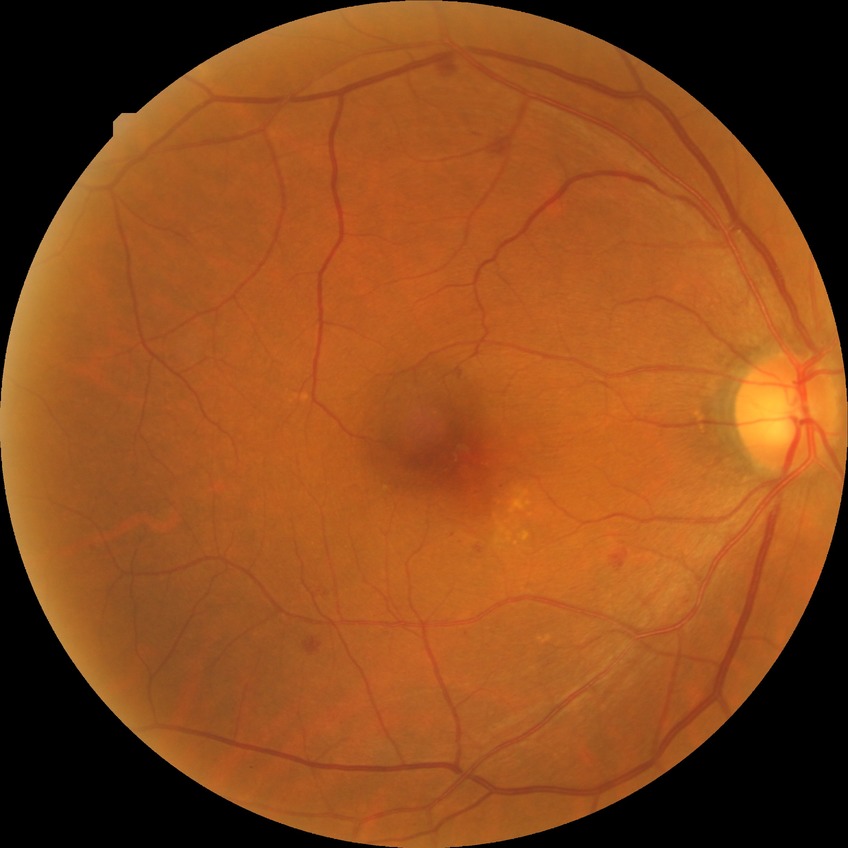

Diabetic retinopathy stage: simple diabetic retinopathy.
DR class: non-proliferative diabetic retinopathy.